CFP.
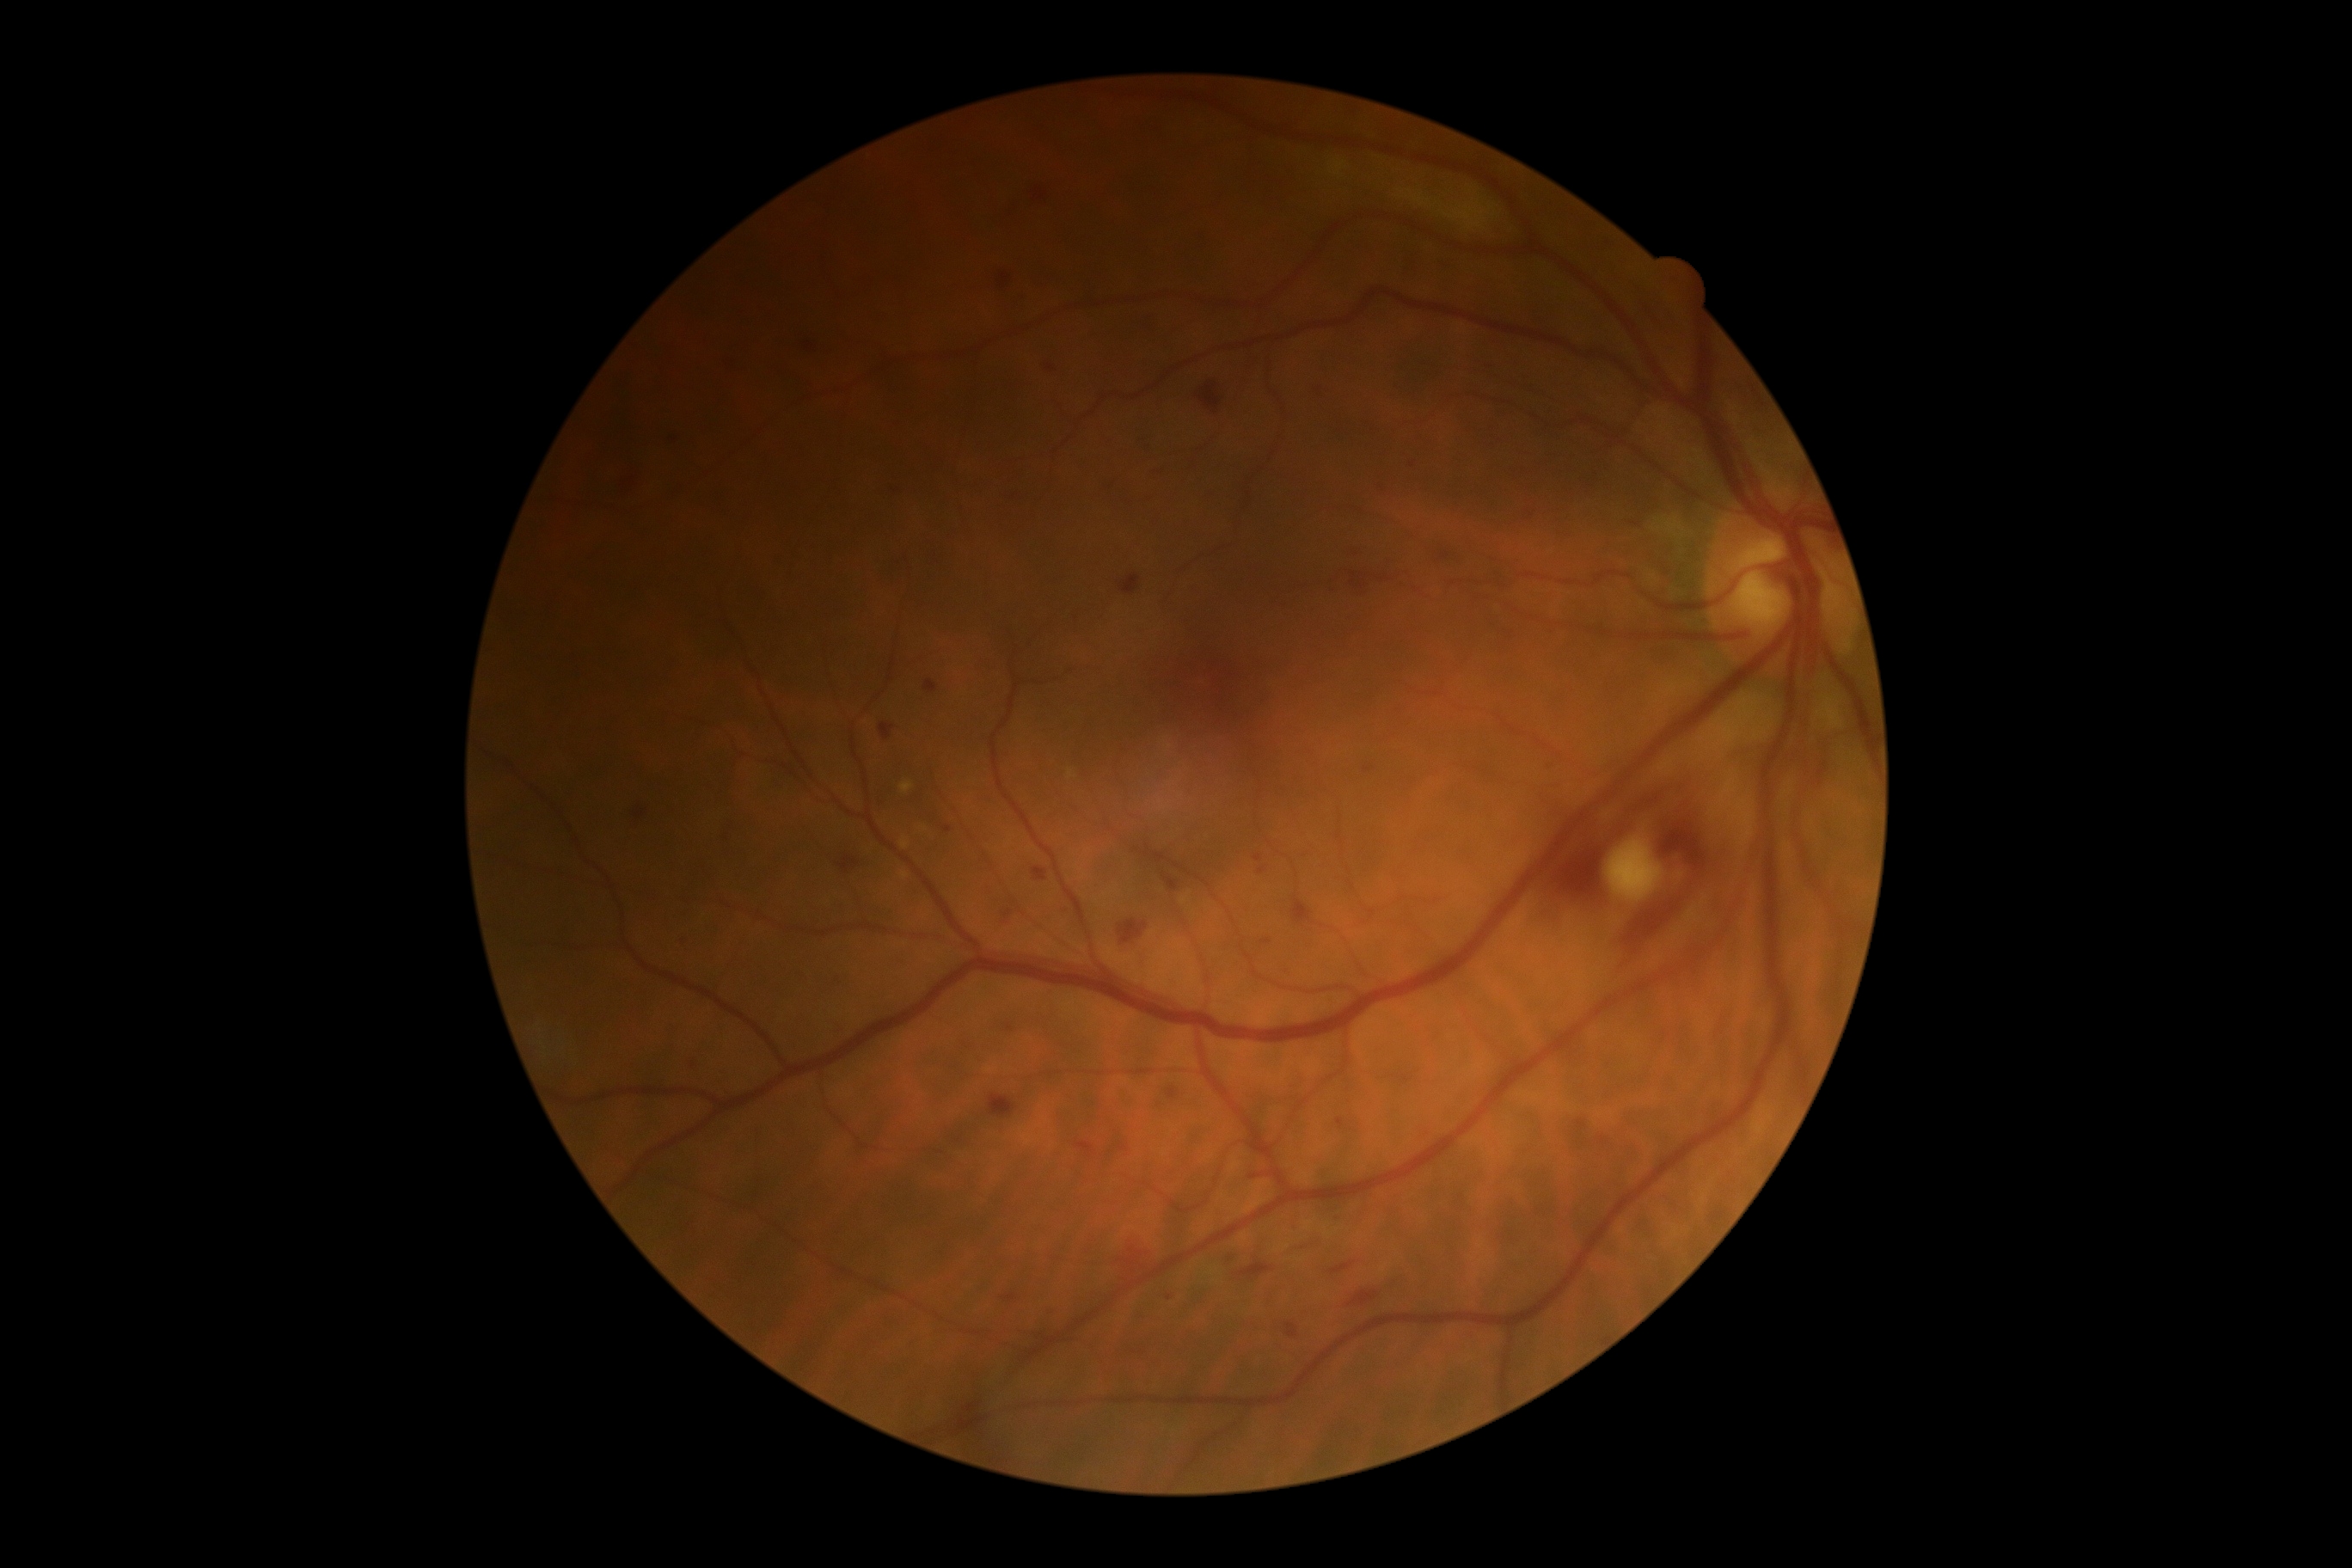
DR severity: moderate non-proliferative diabetic retinopathy (grade 2).